Wide-field fundus photograph of an infant — 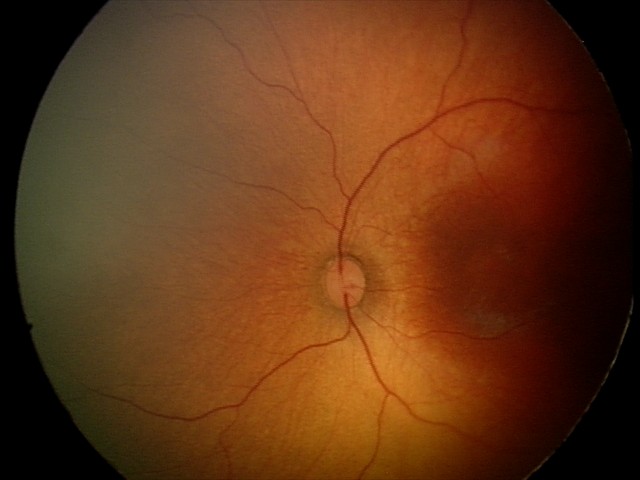

Screening examination with no abnormal retinal findings.